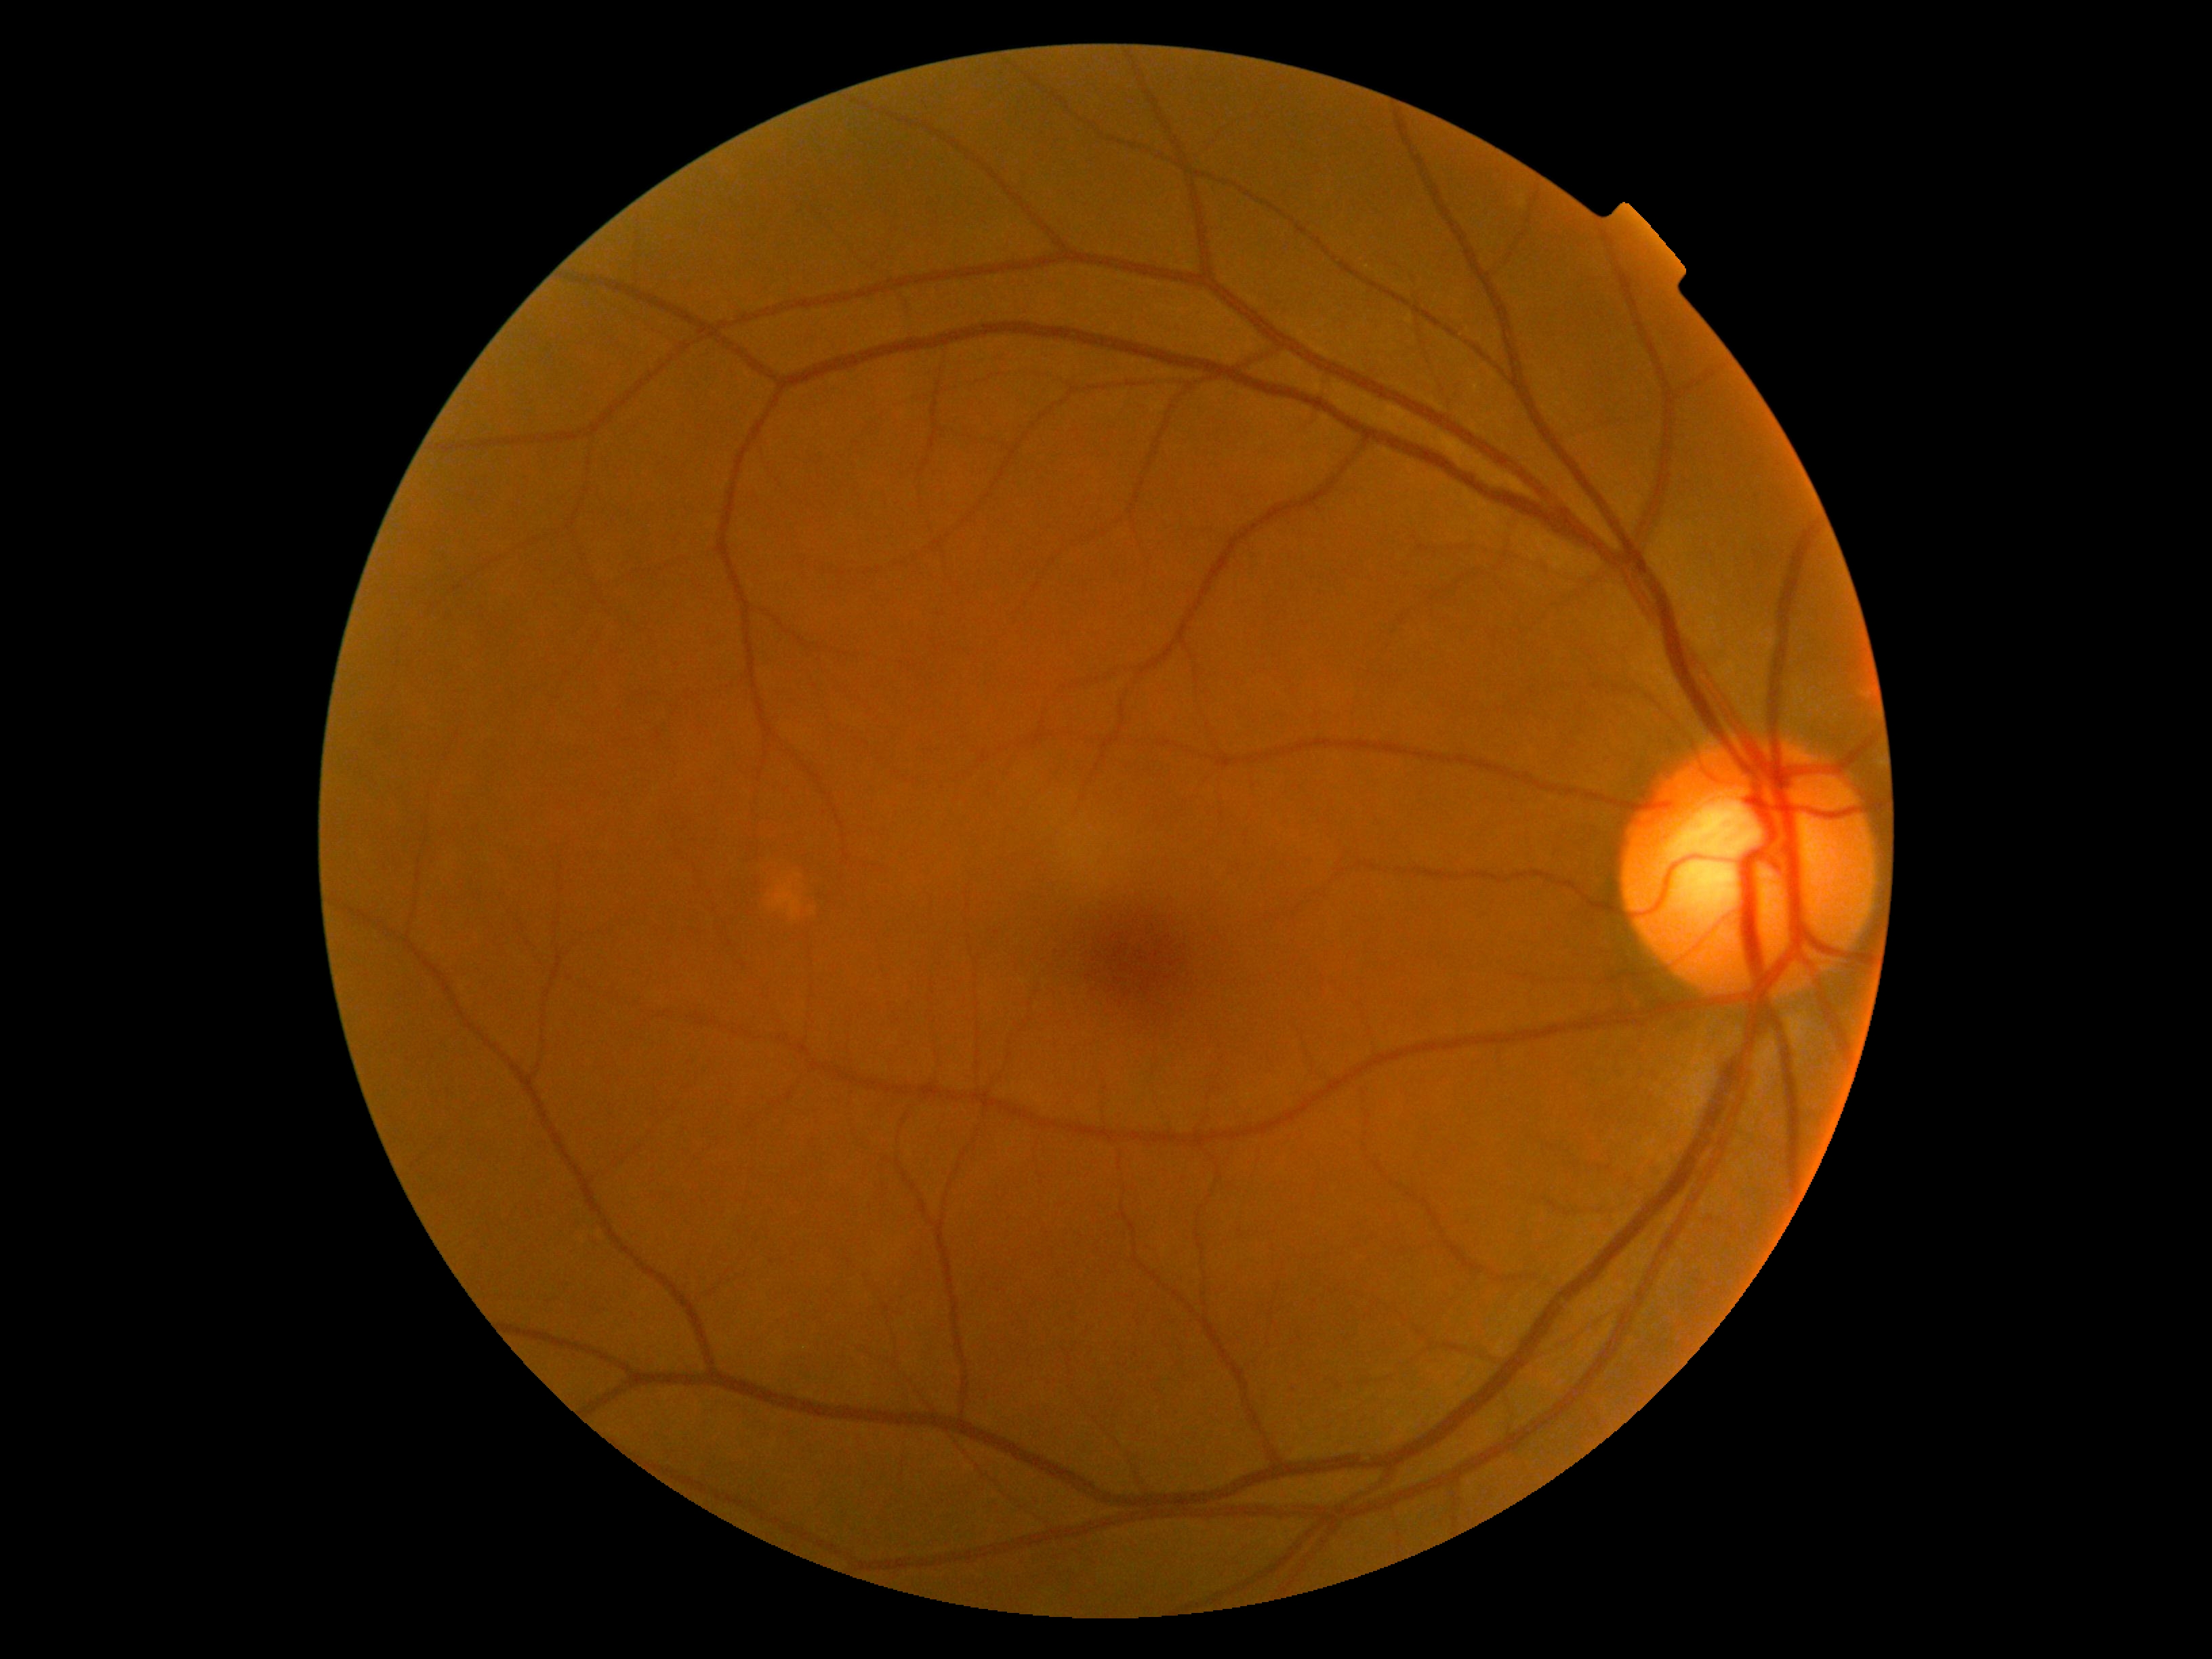
Diabetic retinopathy is 0/4.